Handheld portable fundus camera image
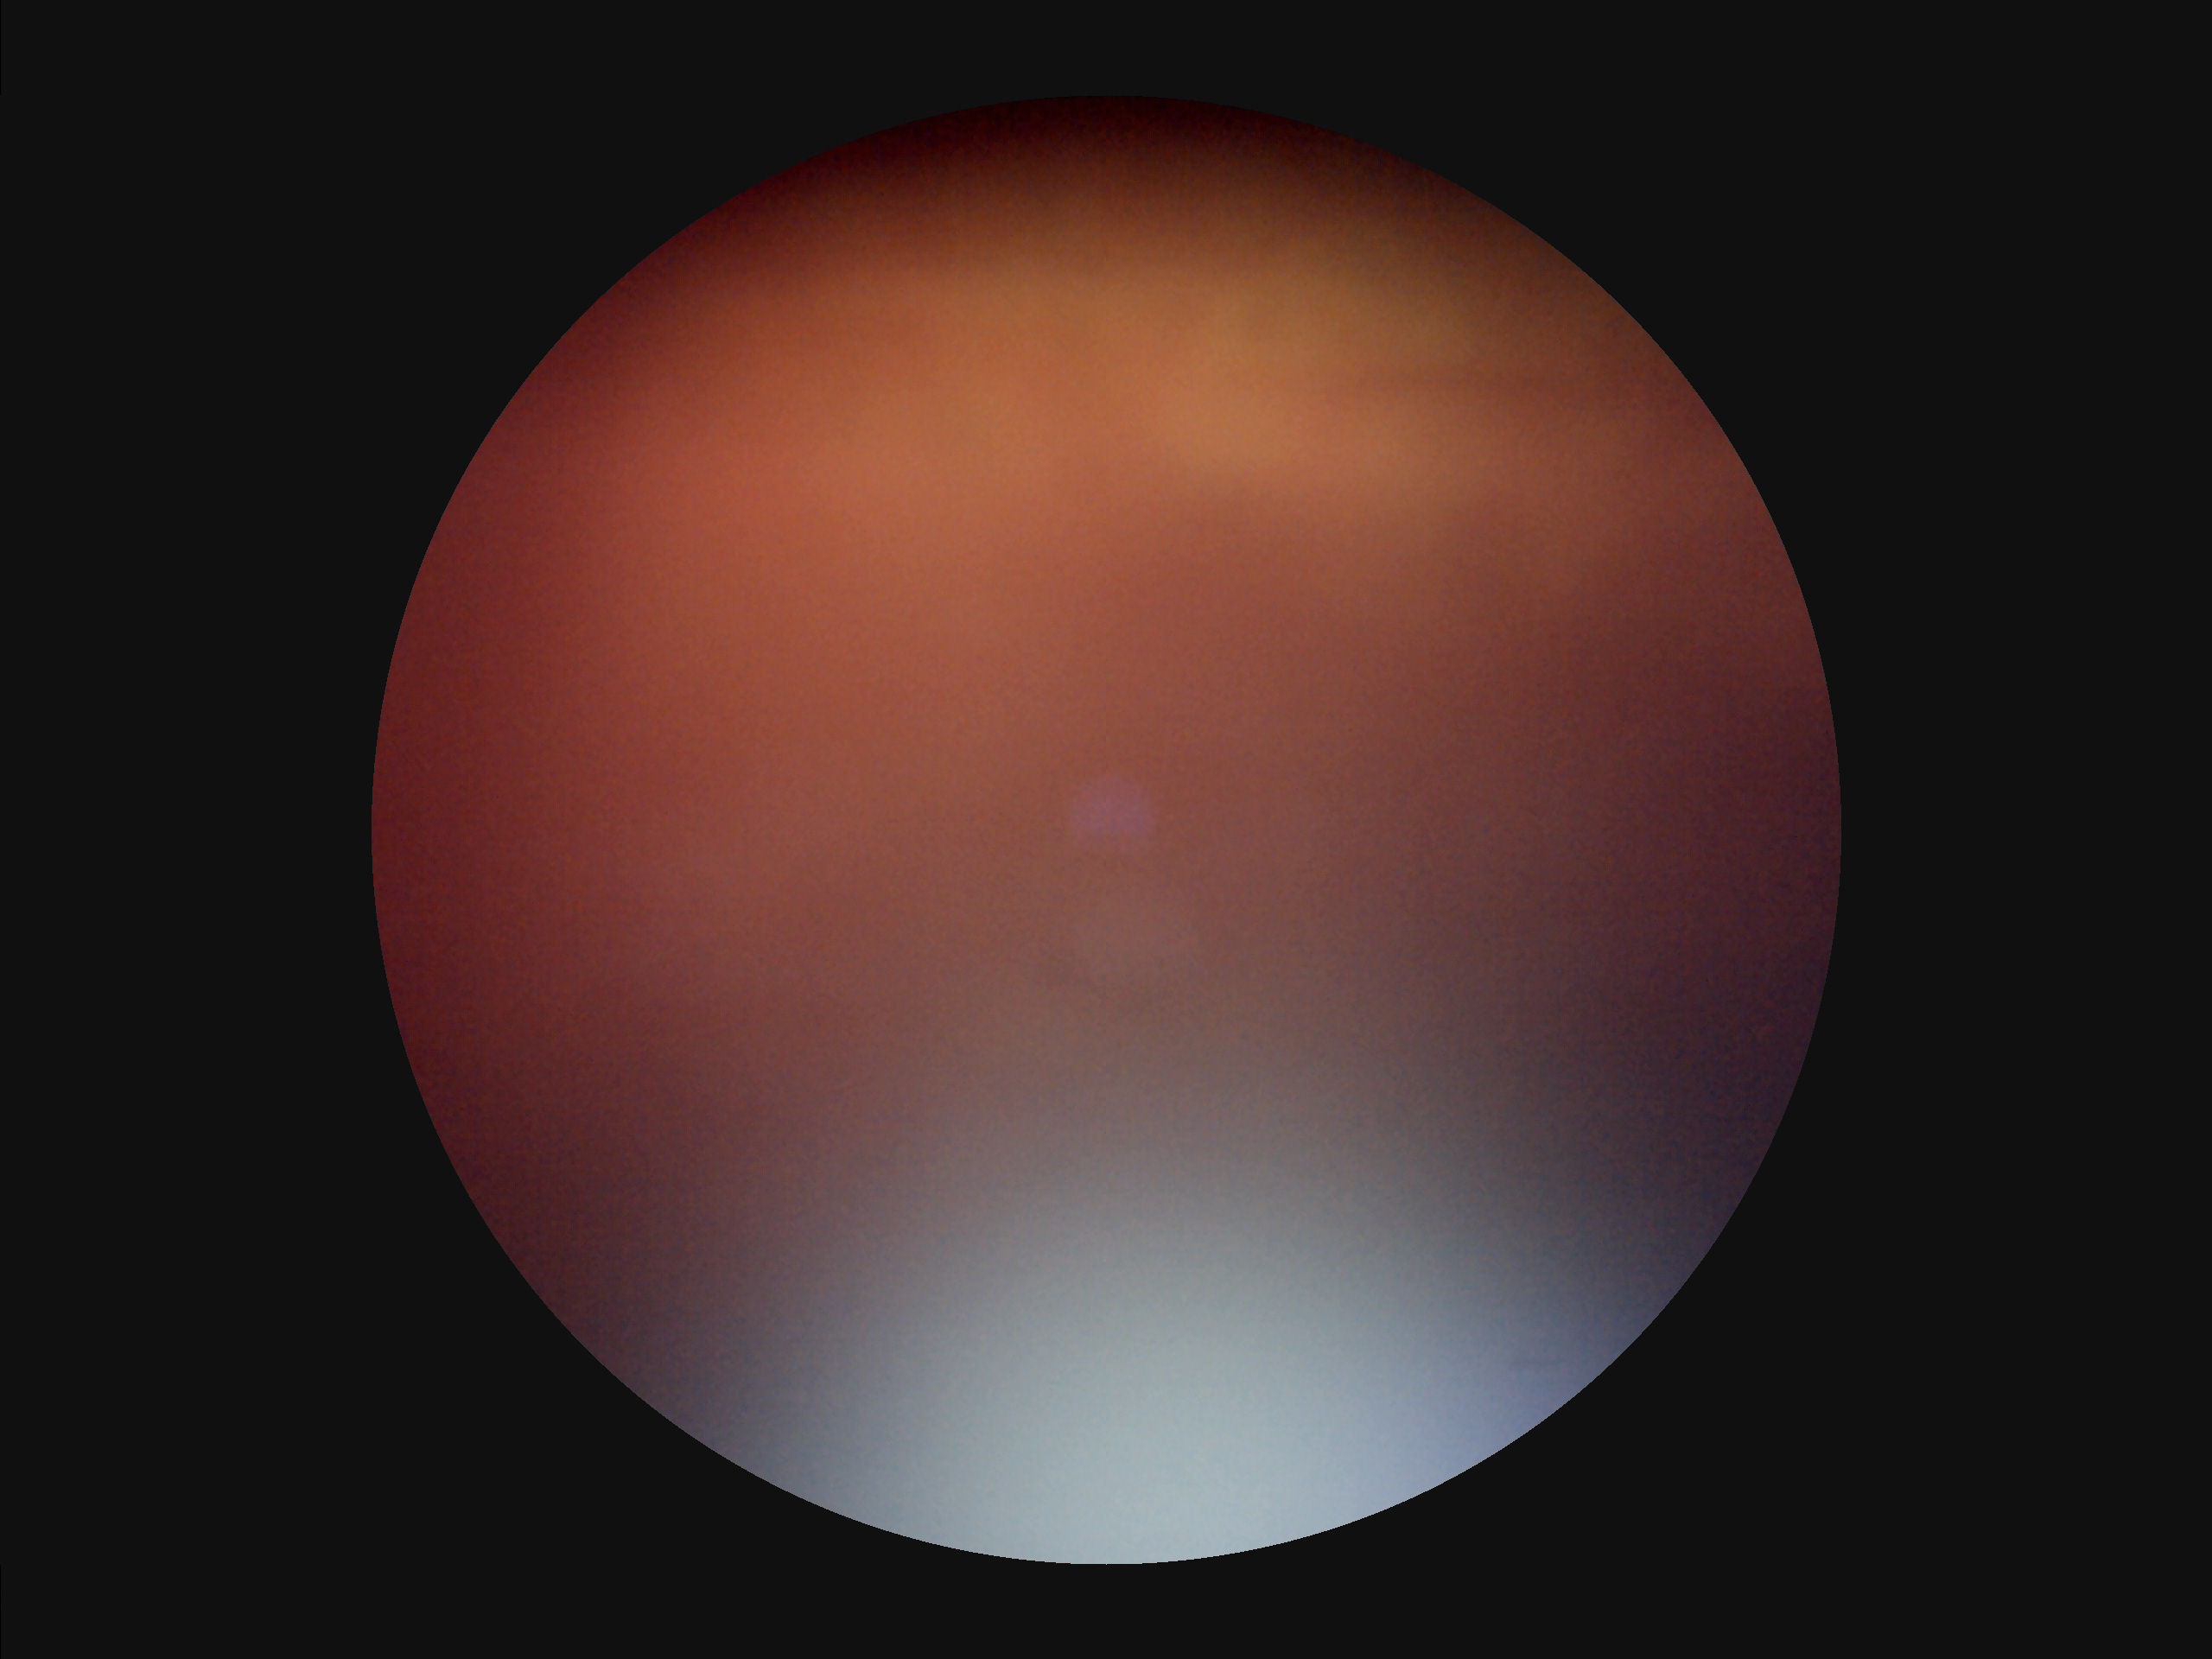

Narrow intensity range; structures are hard to distinguish.
Image quality is suboptimal.
The image is blurry.
Poor illumination with uneven exposure.